Color fundus photograph, image size 2048x1536, 45-degree field of view — 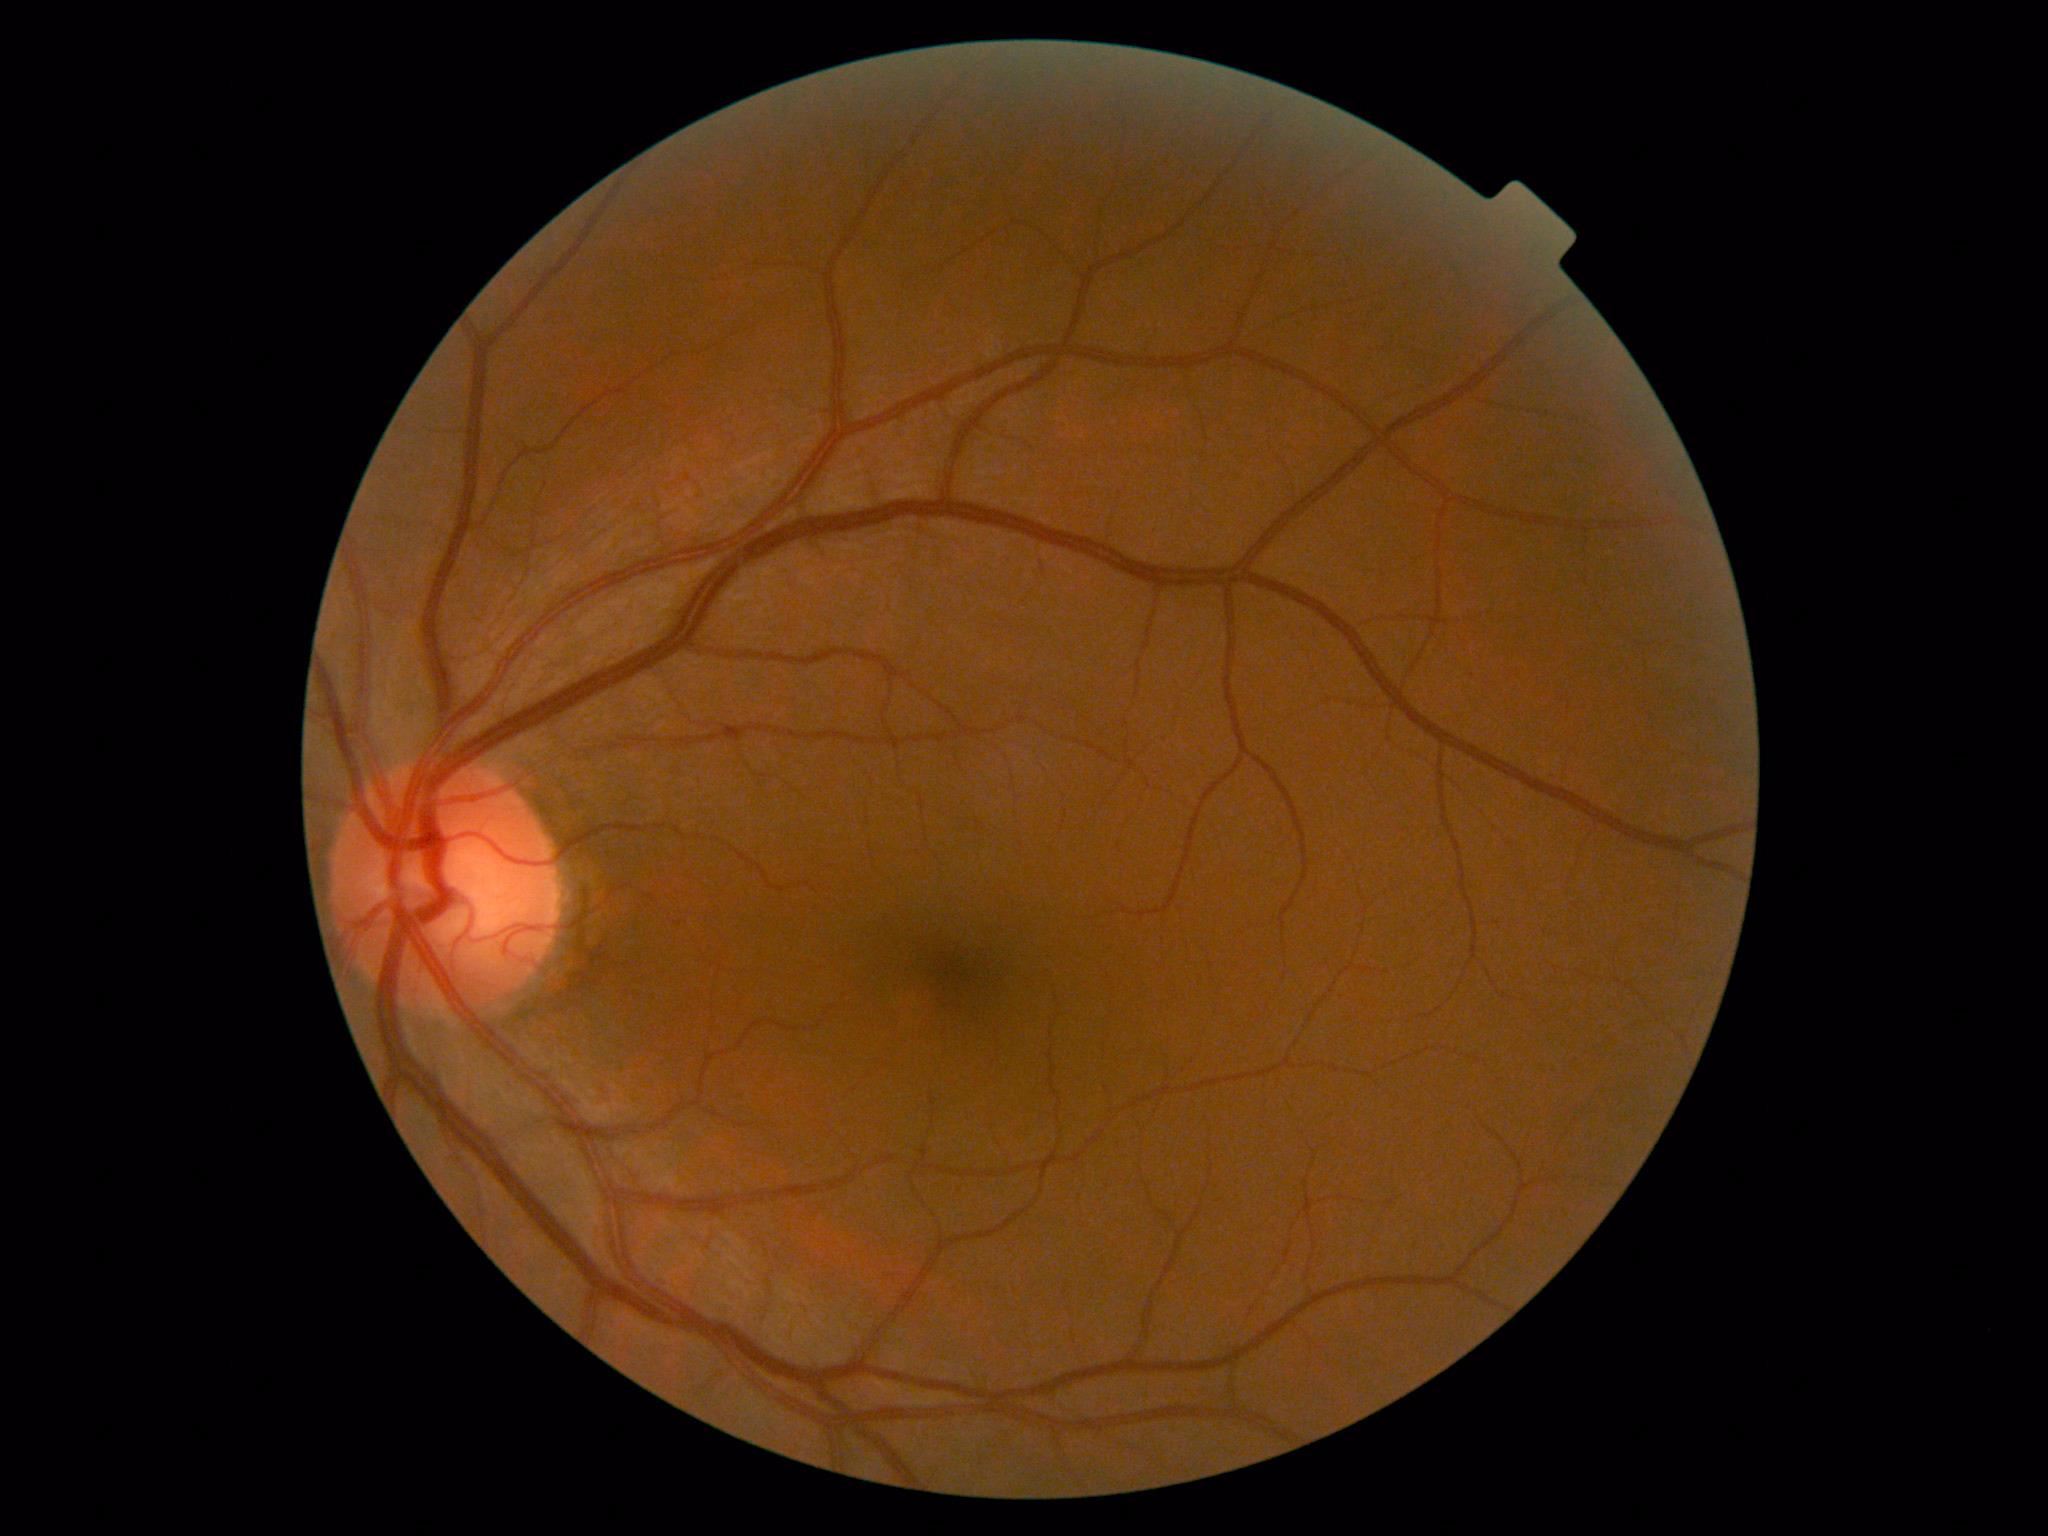 No diabetic retinal disease findings.
DR stage is no apparent retinopathy (grade 0).